Fundus photo
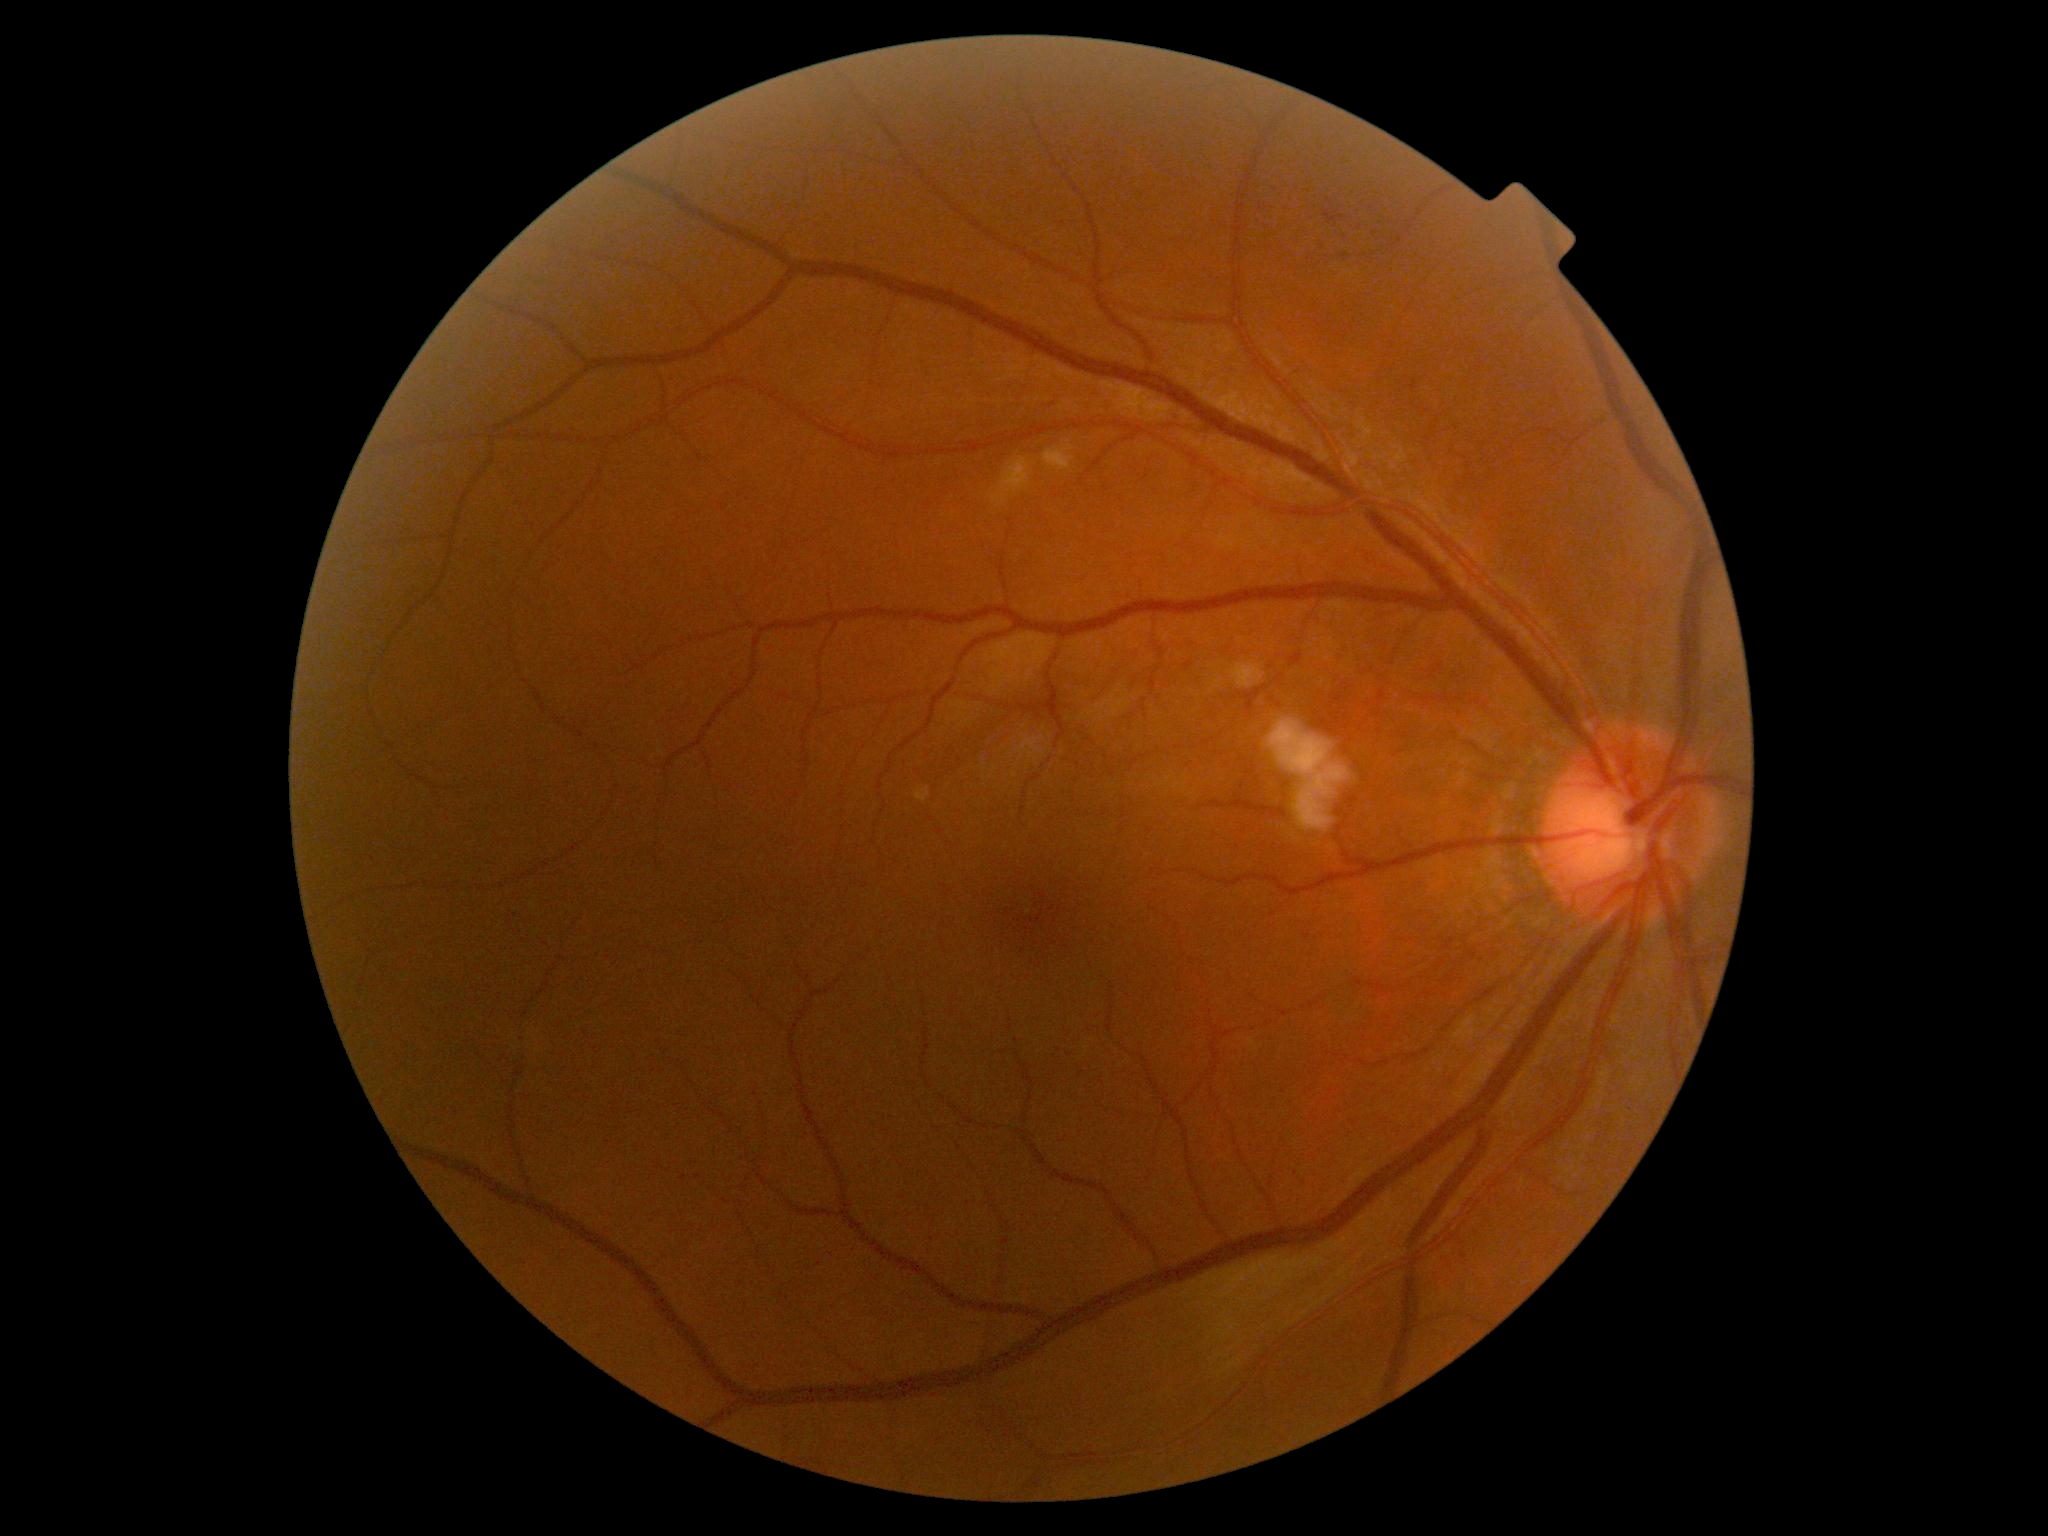 diabetic retinopathy severity=2/4.